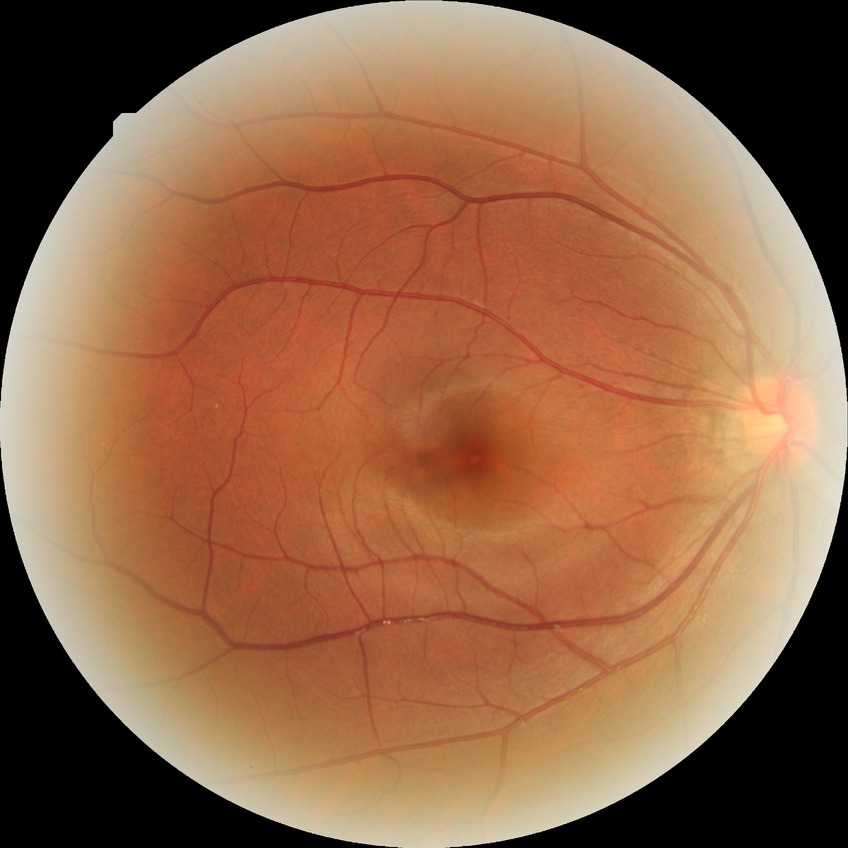 DR severity: NDR, DR impression: no DR findings.